Image size 1932x1910, 45° FOV — 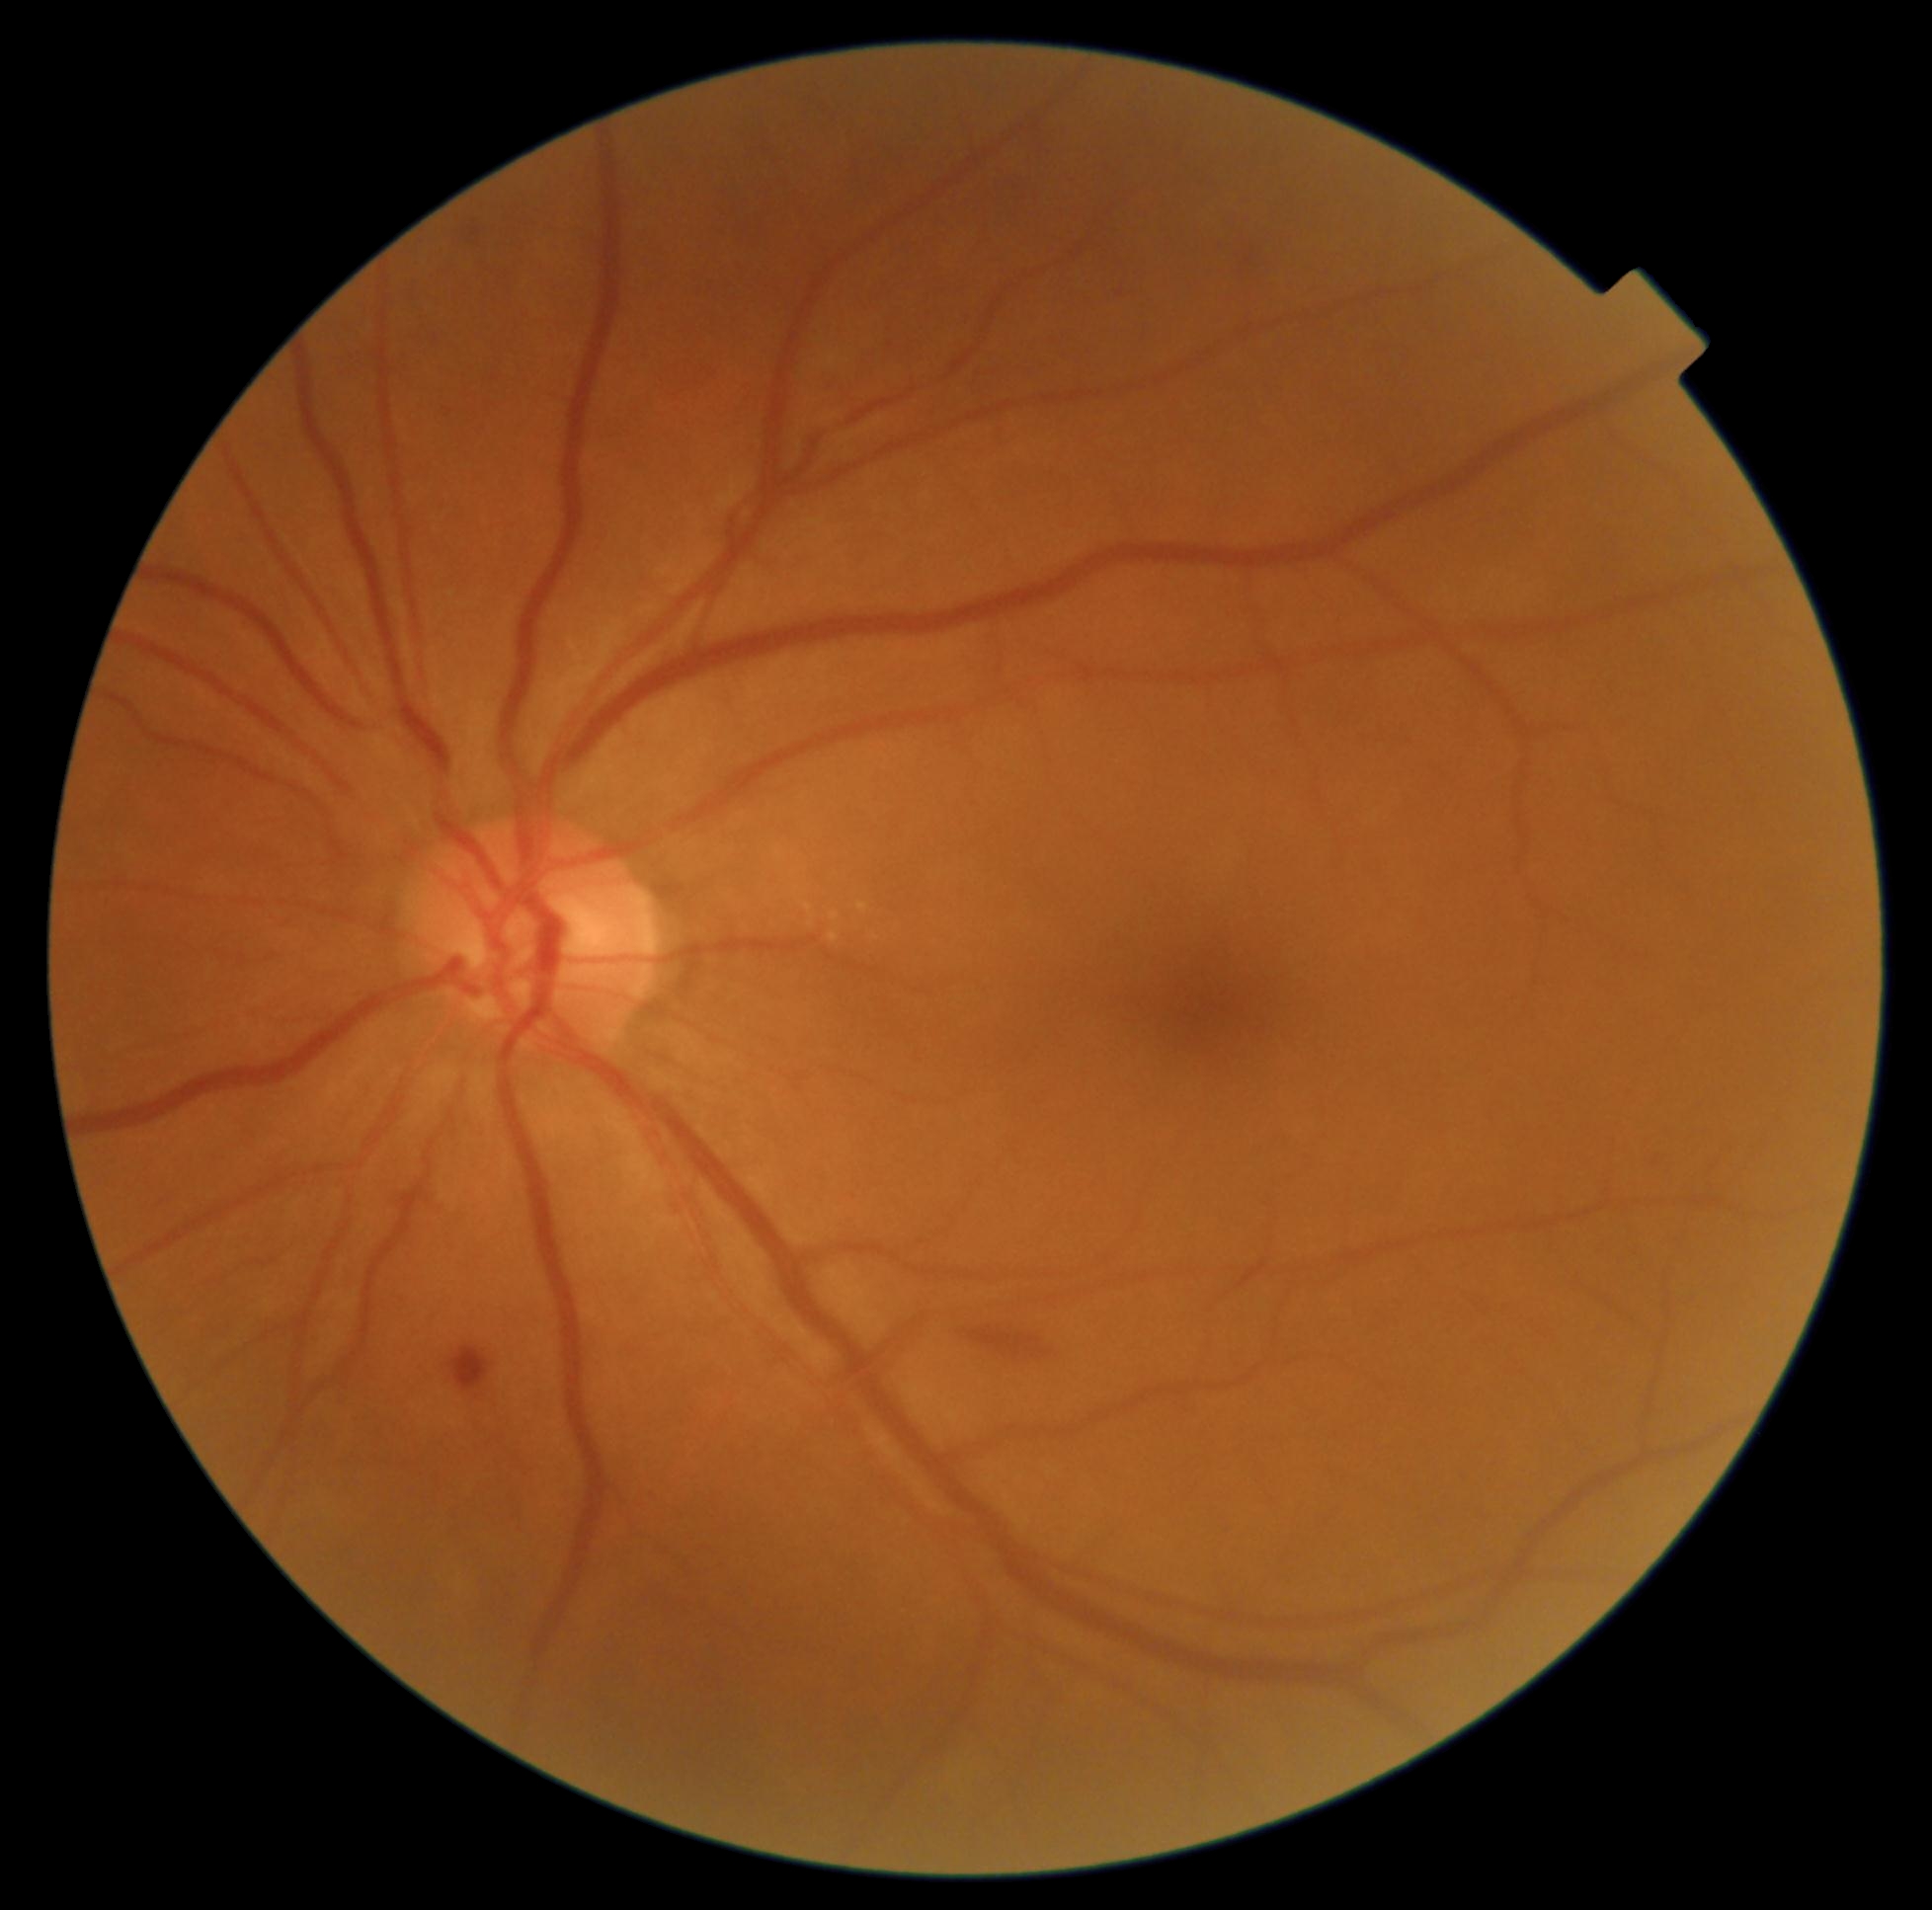 Diabetic retinopathy grade: moderate NPDR (2) — more than just microaneurysms but less than severe NPDR
microaneurysms: none
soft exudates: none
hard exudates: box(830, 933, 841, 942) | box(858, 903, 869, 914) | box(806, 908, 817, 917) | box(832, 914, 841, 920)
Smaller hard exudates around point(876, 938)
hemorrhages: box(962, 1318, 1061, 1367) | box(451, 1347, 491, 1392) | box(458, 212, 491, 252)